2352x1568px. Fundus photo
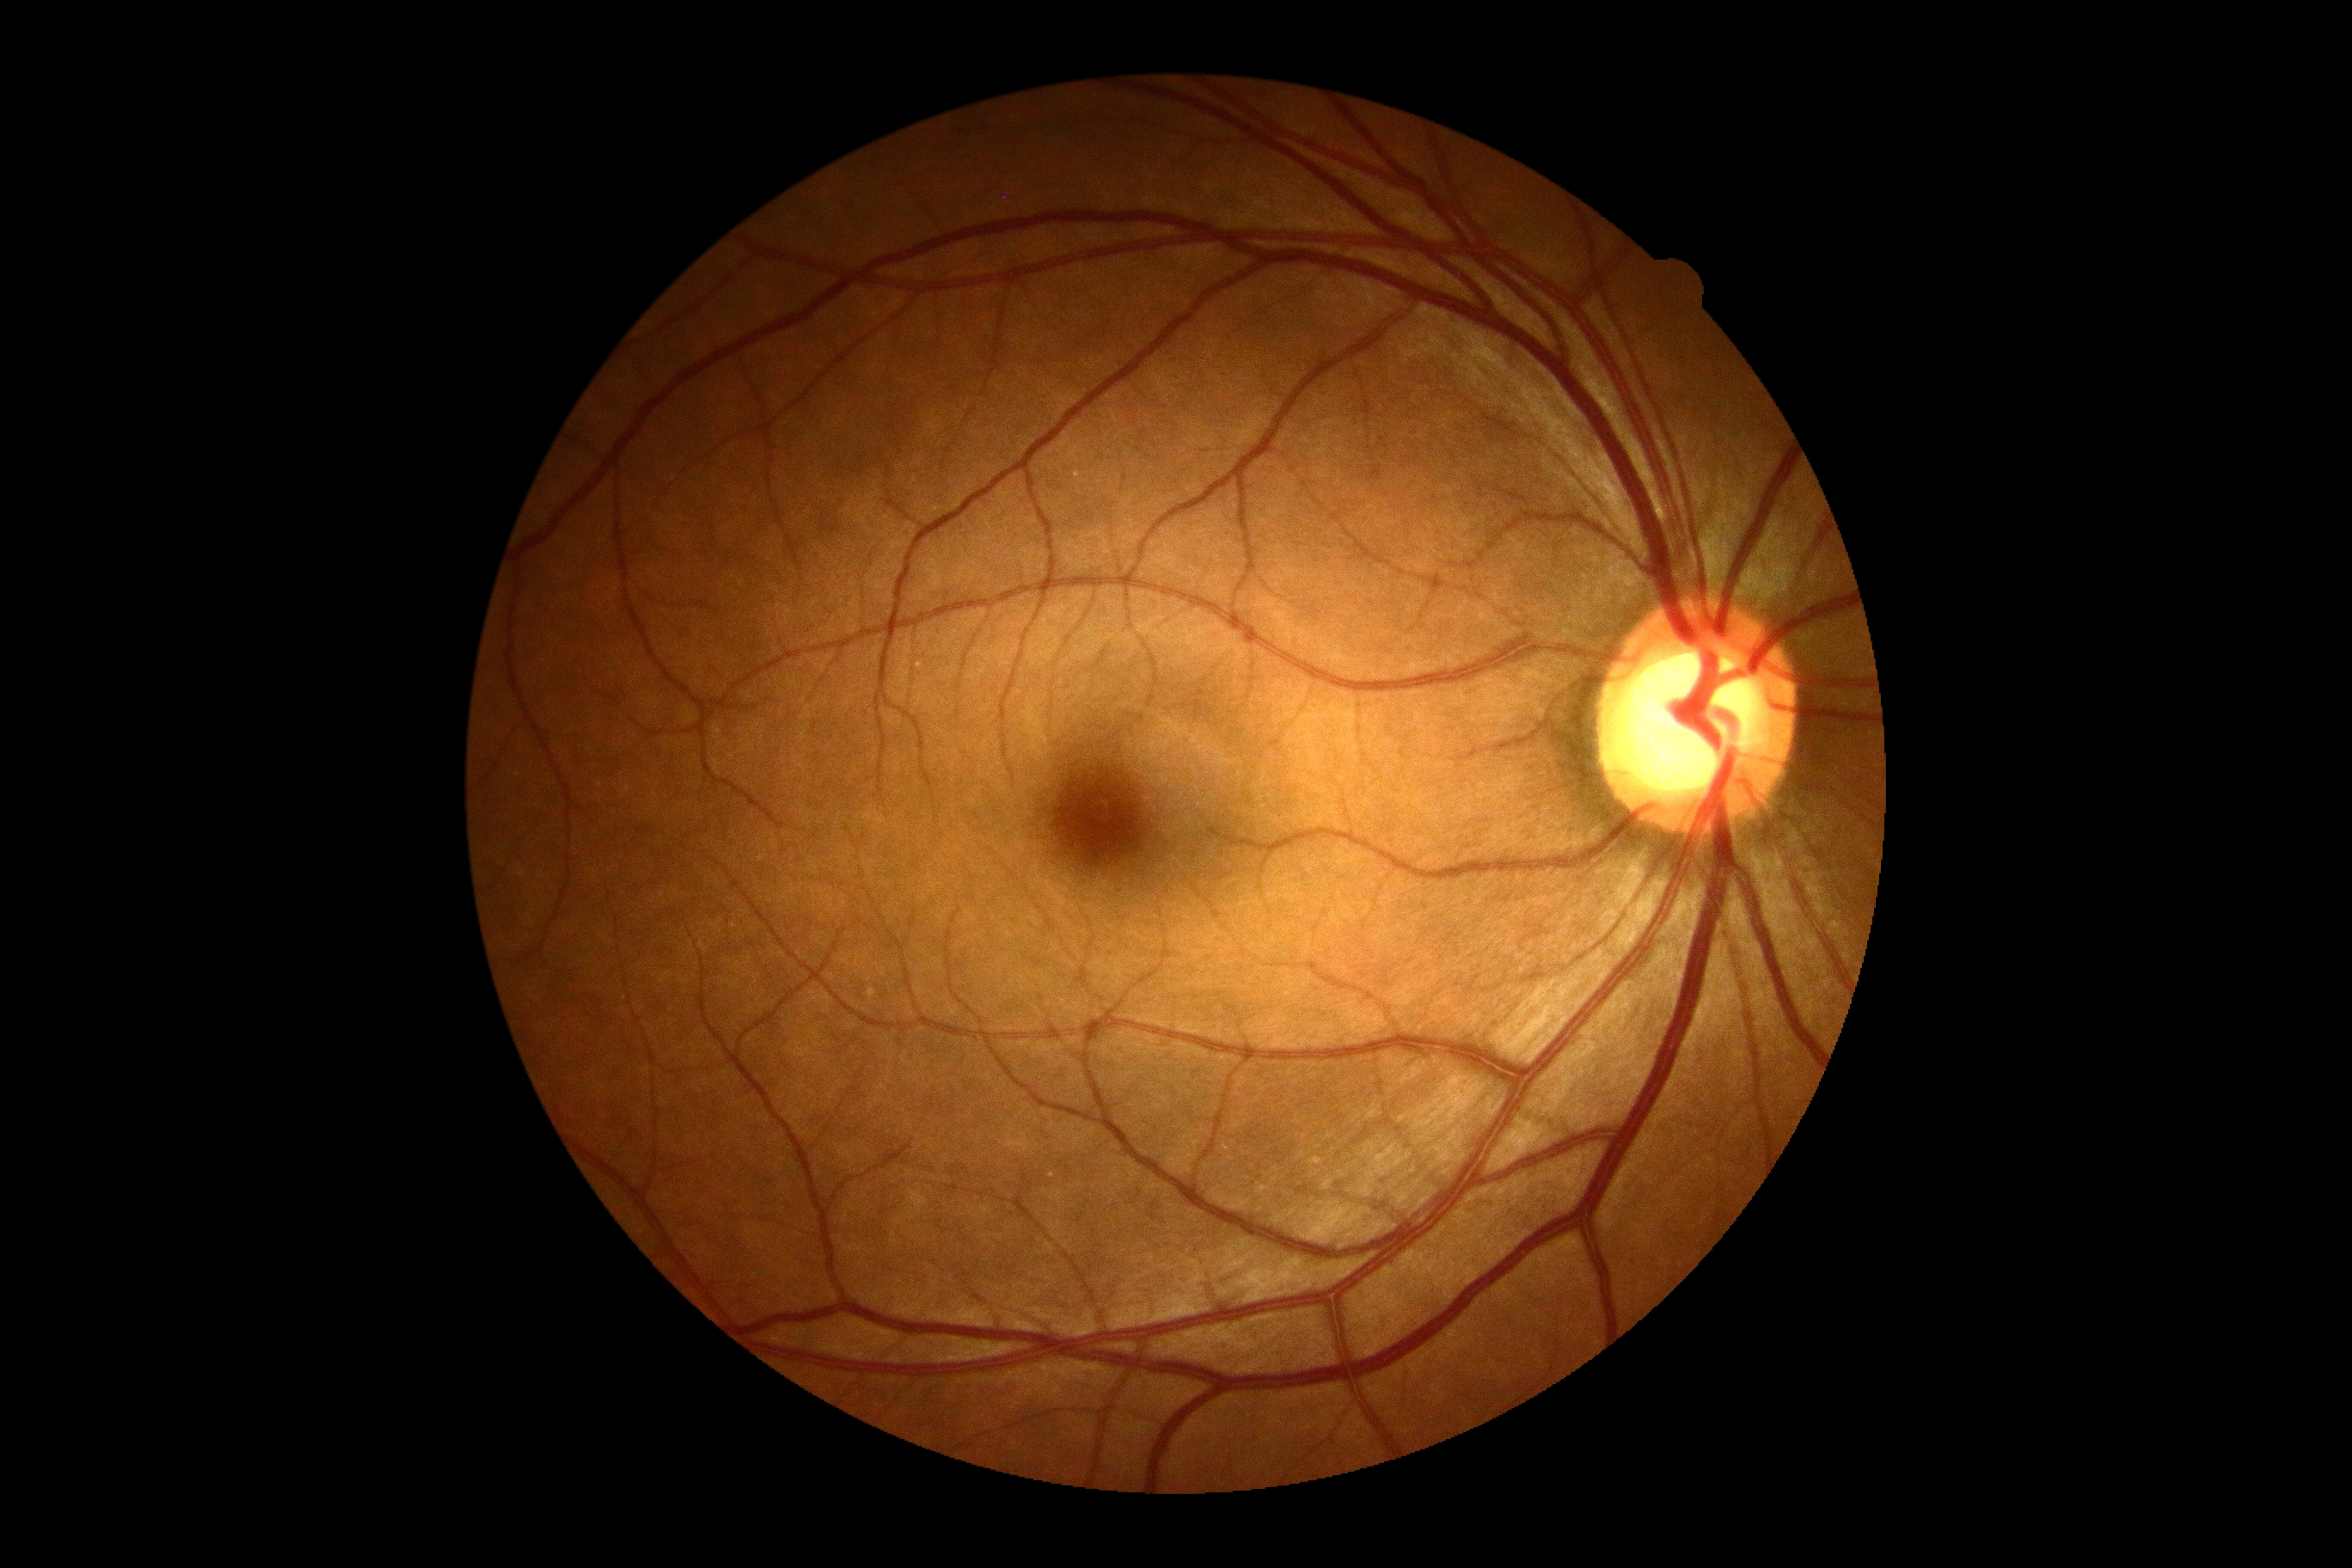
Retinopathy grade is no apparent diabetic retinopathy (0).
No apparent diabetic retinopathy.